Remidio FOP fundus camera:
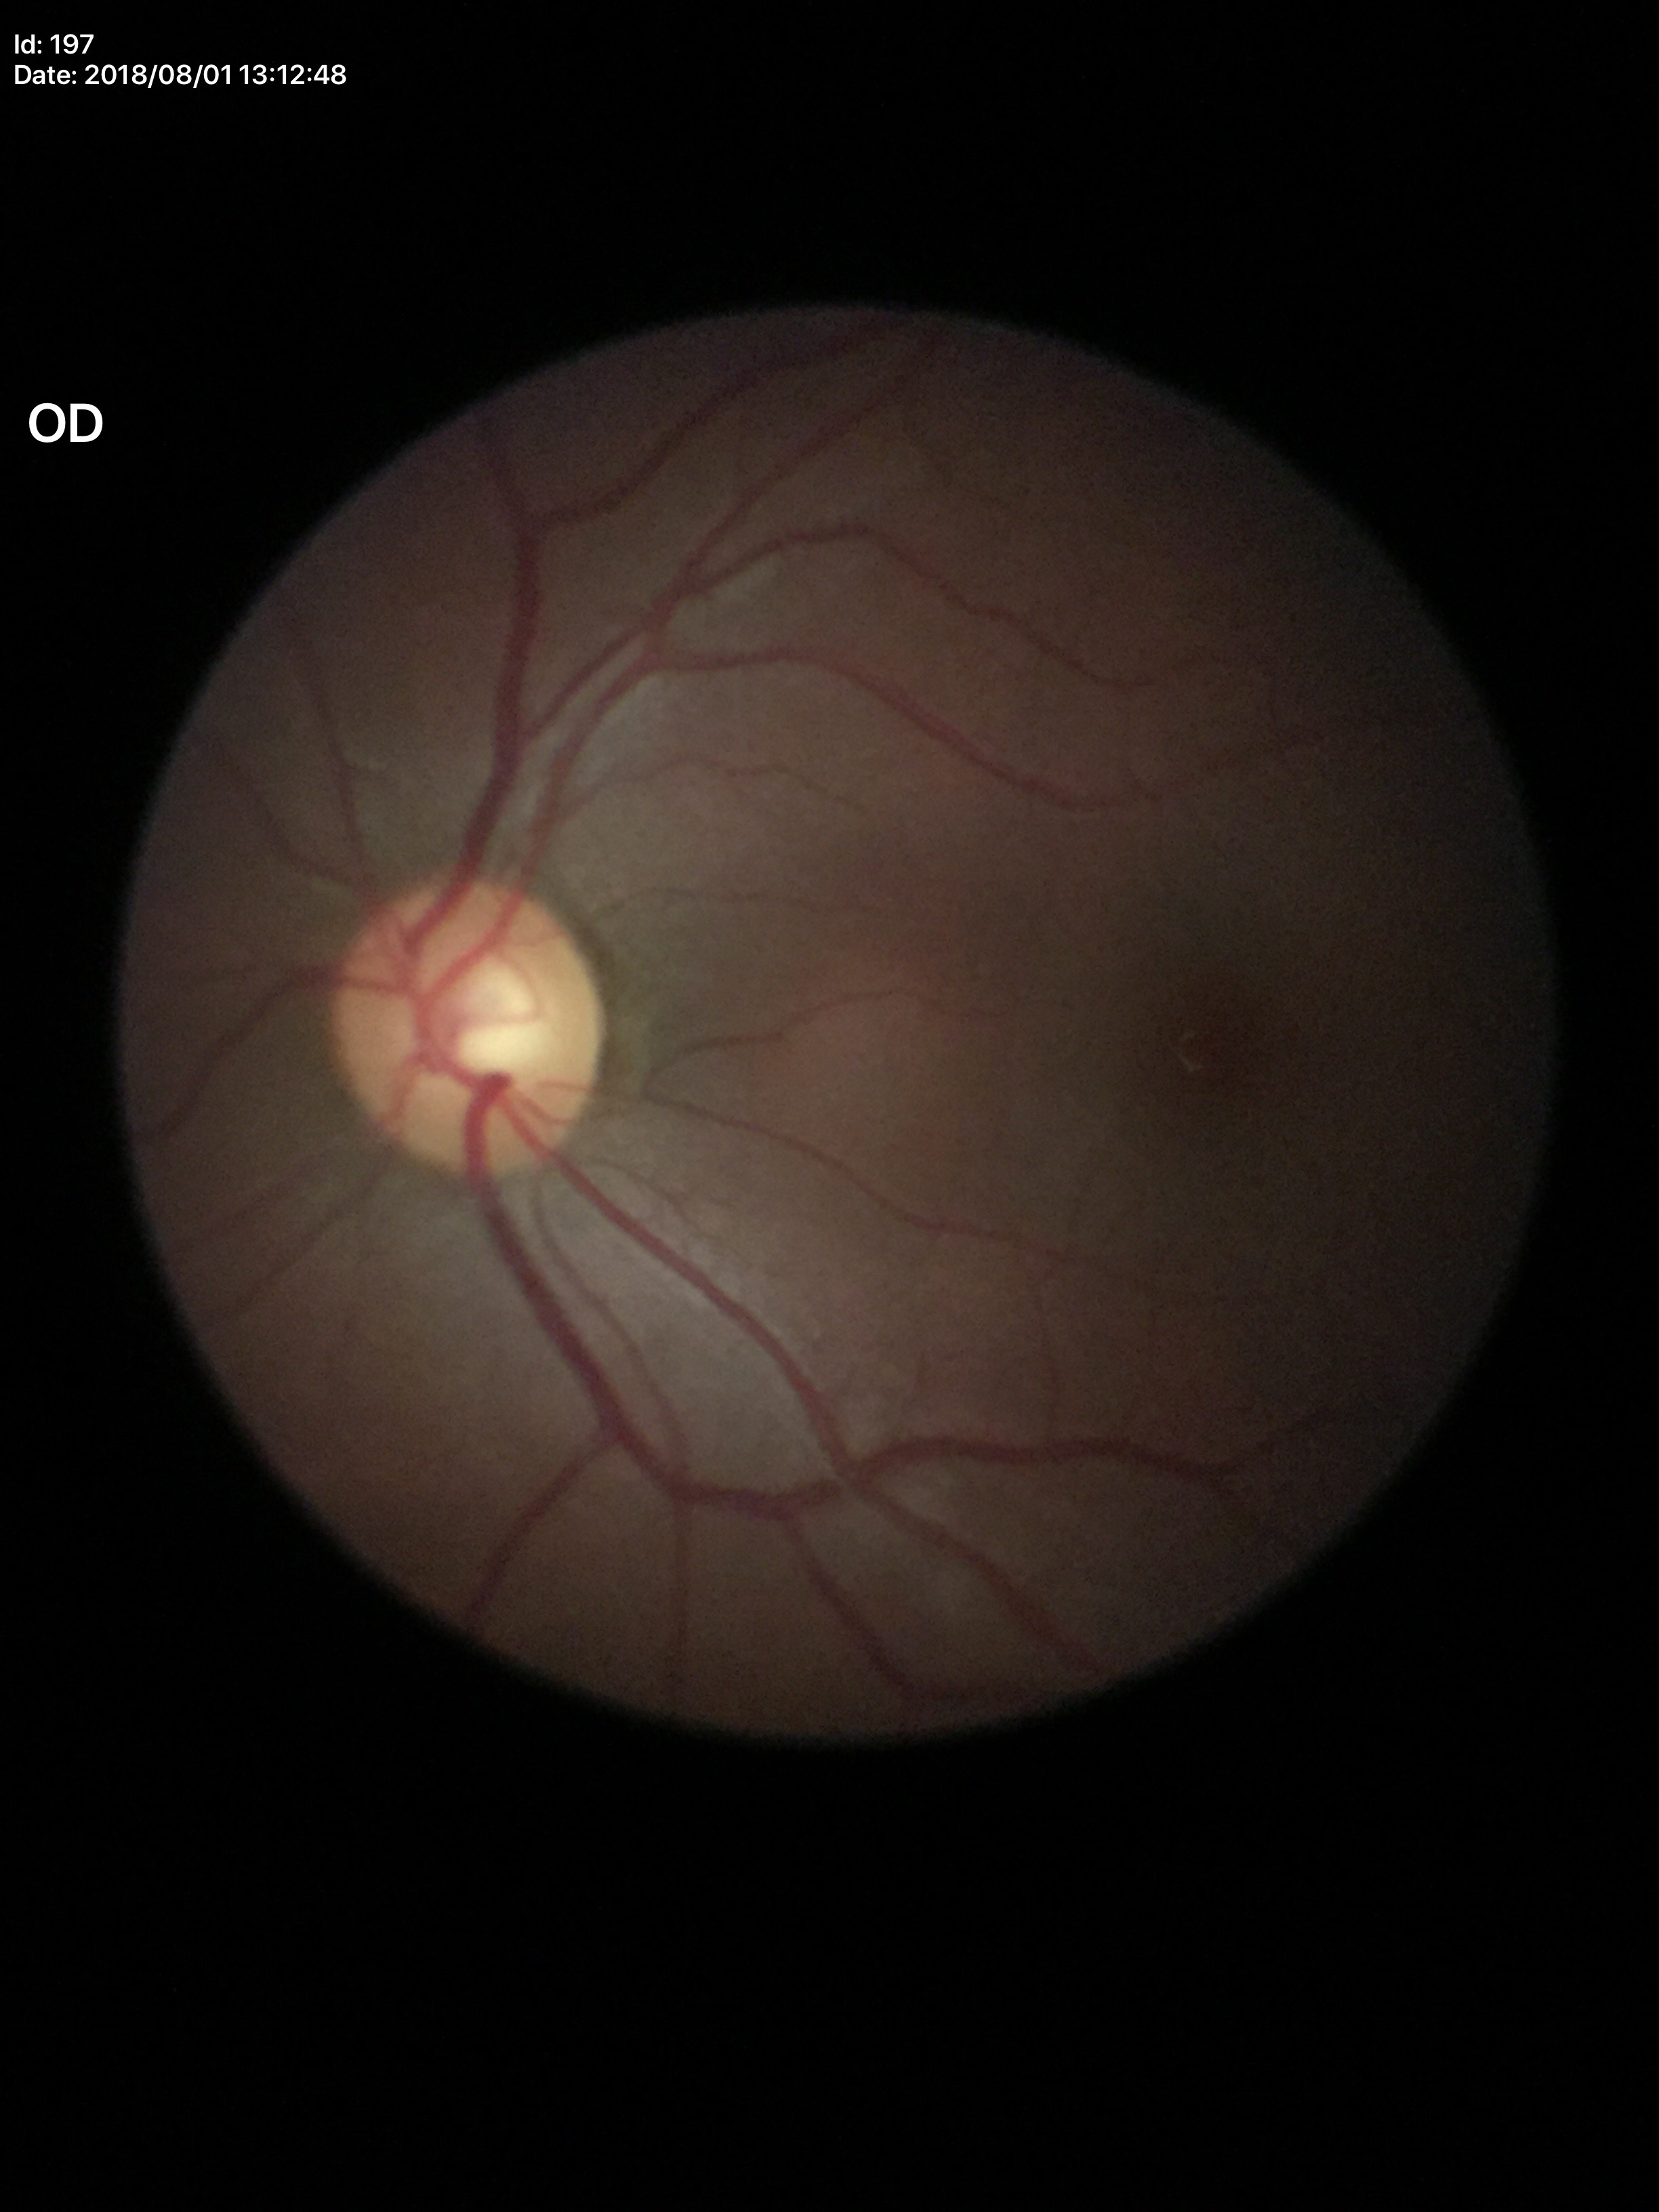
Vertical CDR of 0.55.
Glaucoma screening: no suspicious findings.